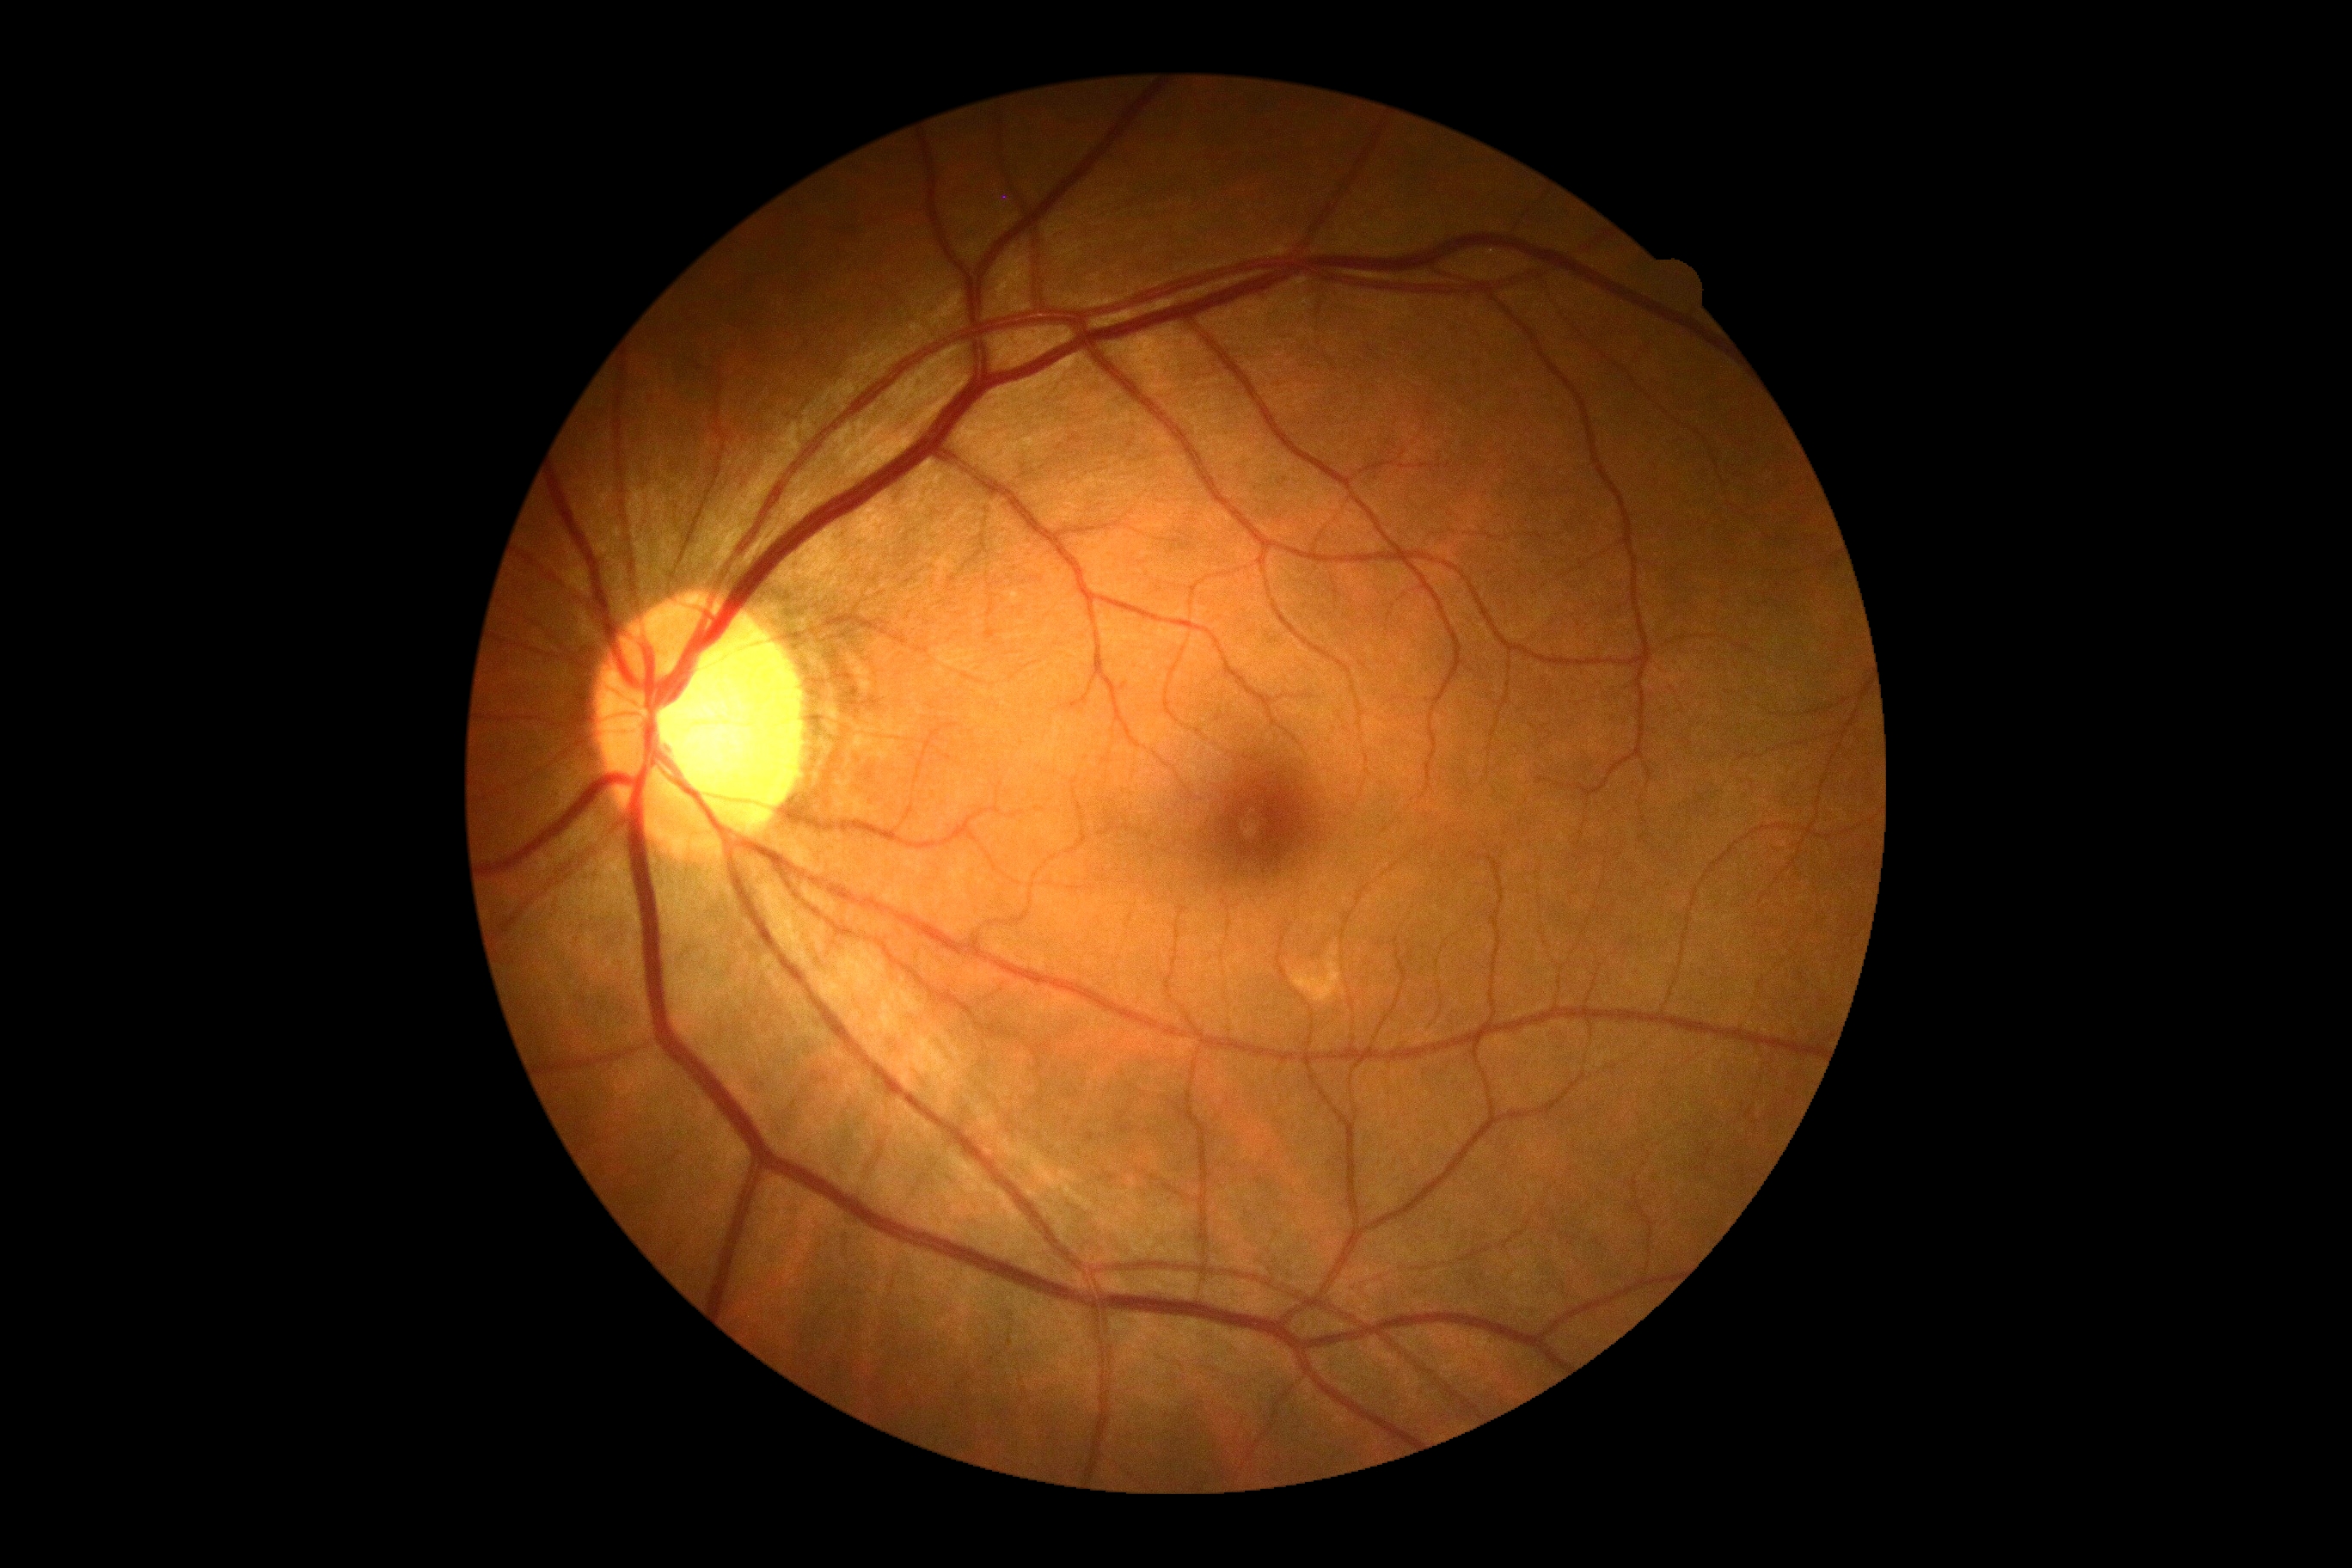 diabetic retinopathy grade = 0